Image size 848x848; modified Davis classification:
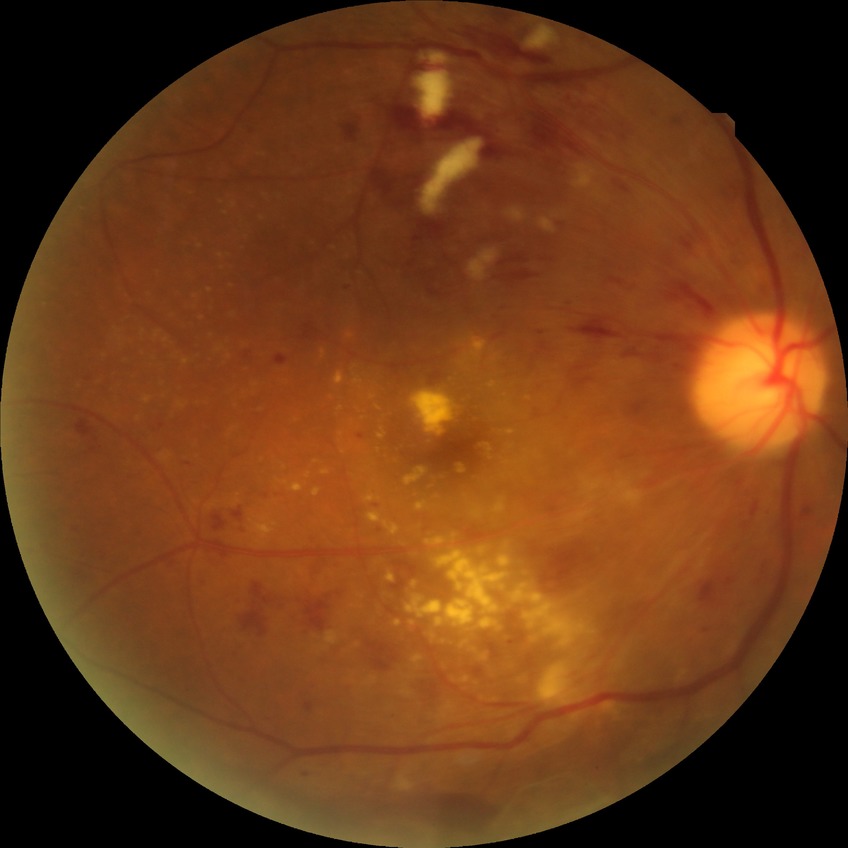 DR grade is PDR.